Color fundus image. DR severity per modified Davis staging: 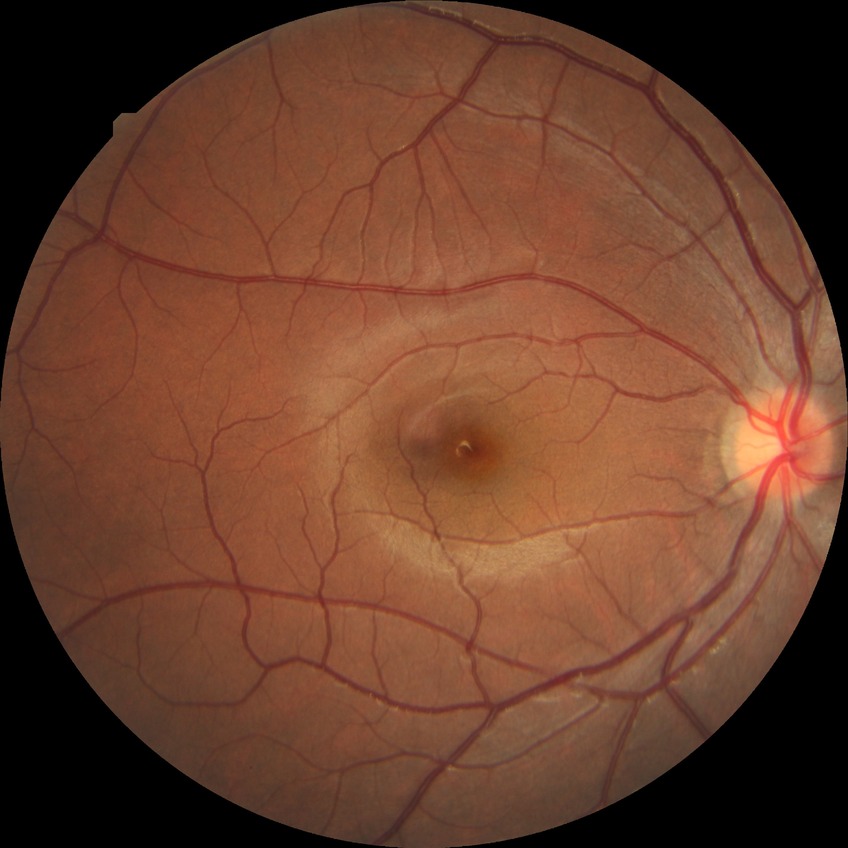
– retinopathy grade: no diabetic retinopathy